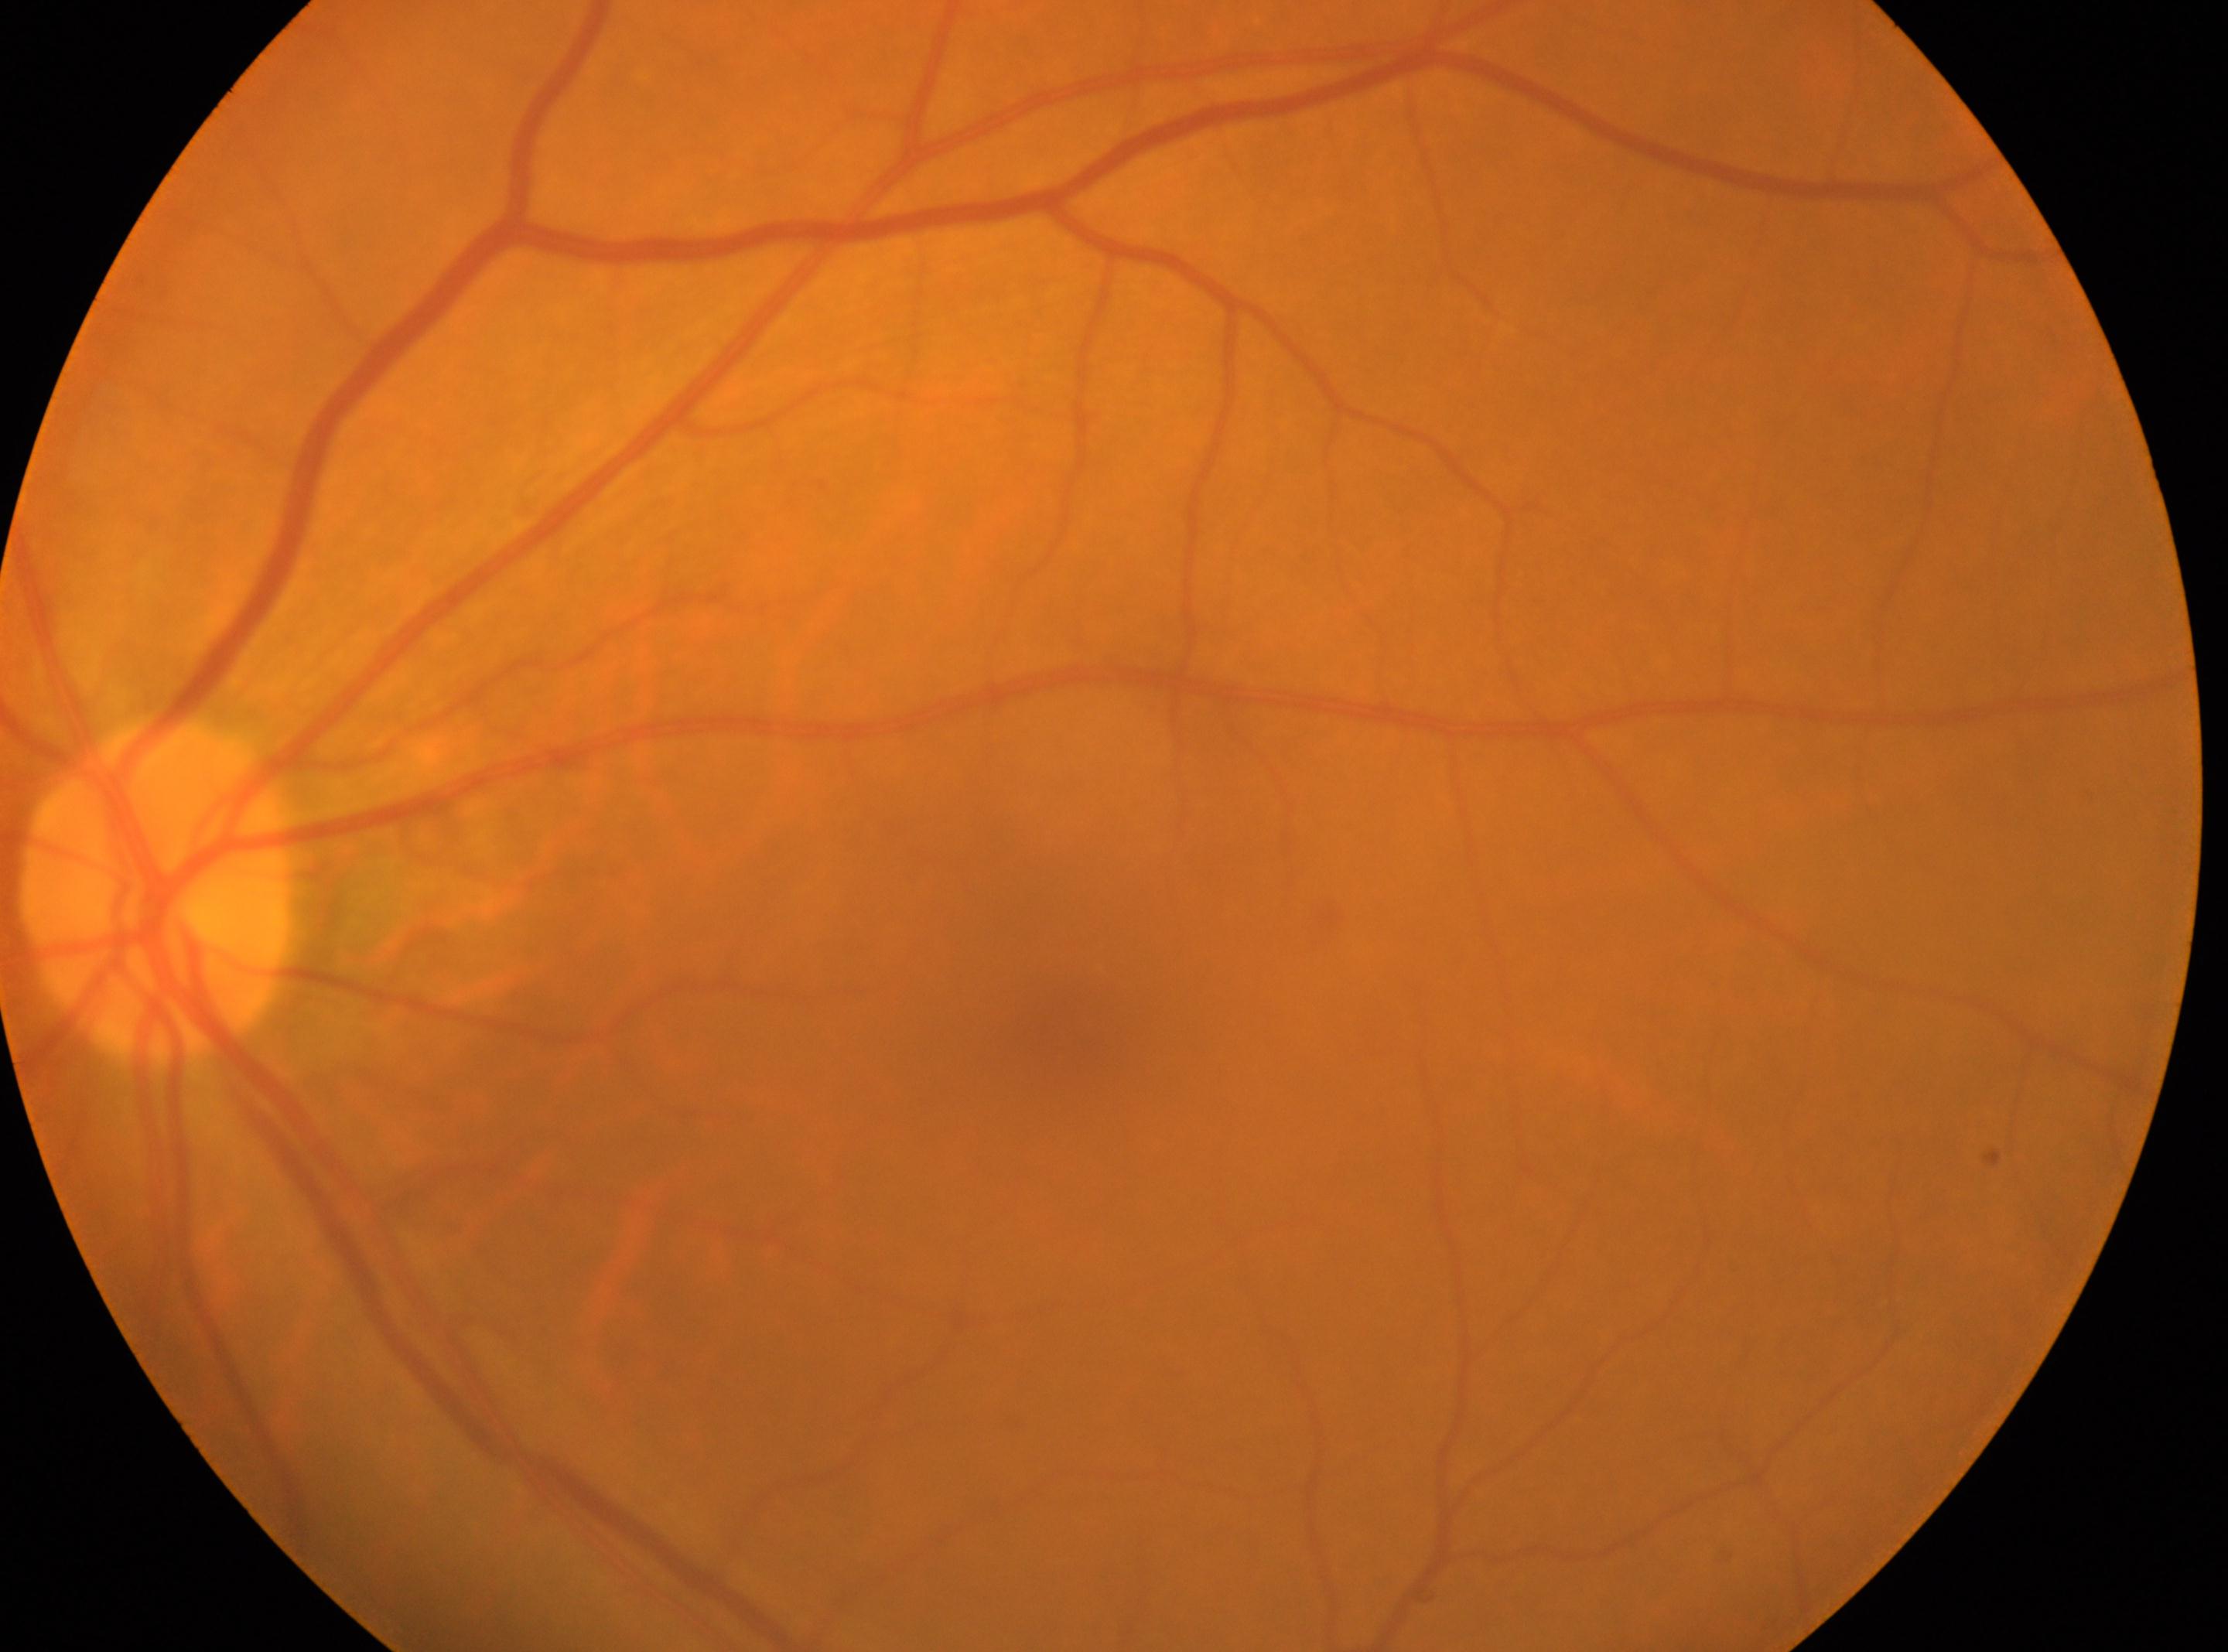

  eye: OS
  dr_grade: no apparent diabetic retinopathy (grade 0)
  fovea: (x=1075, y=1001)
  optic_disc: (x=157, y=889)